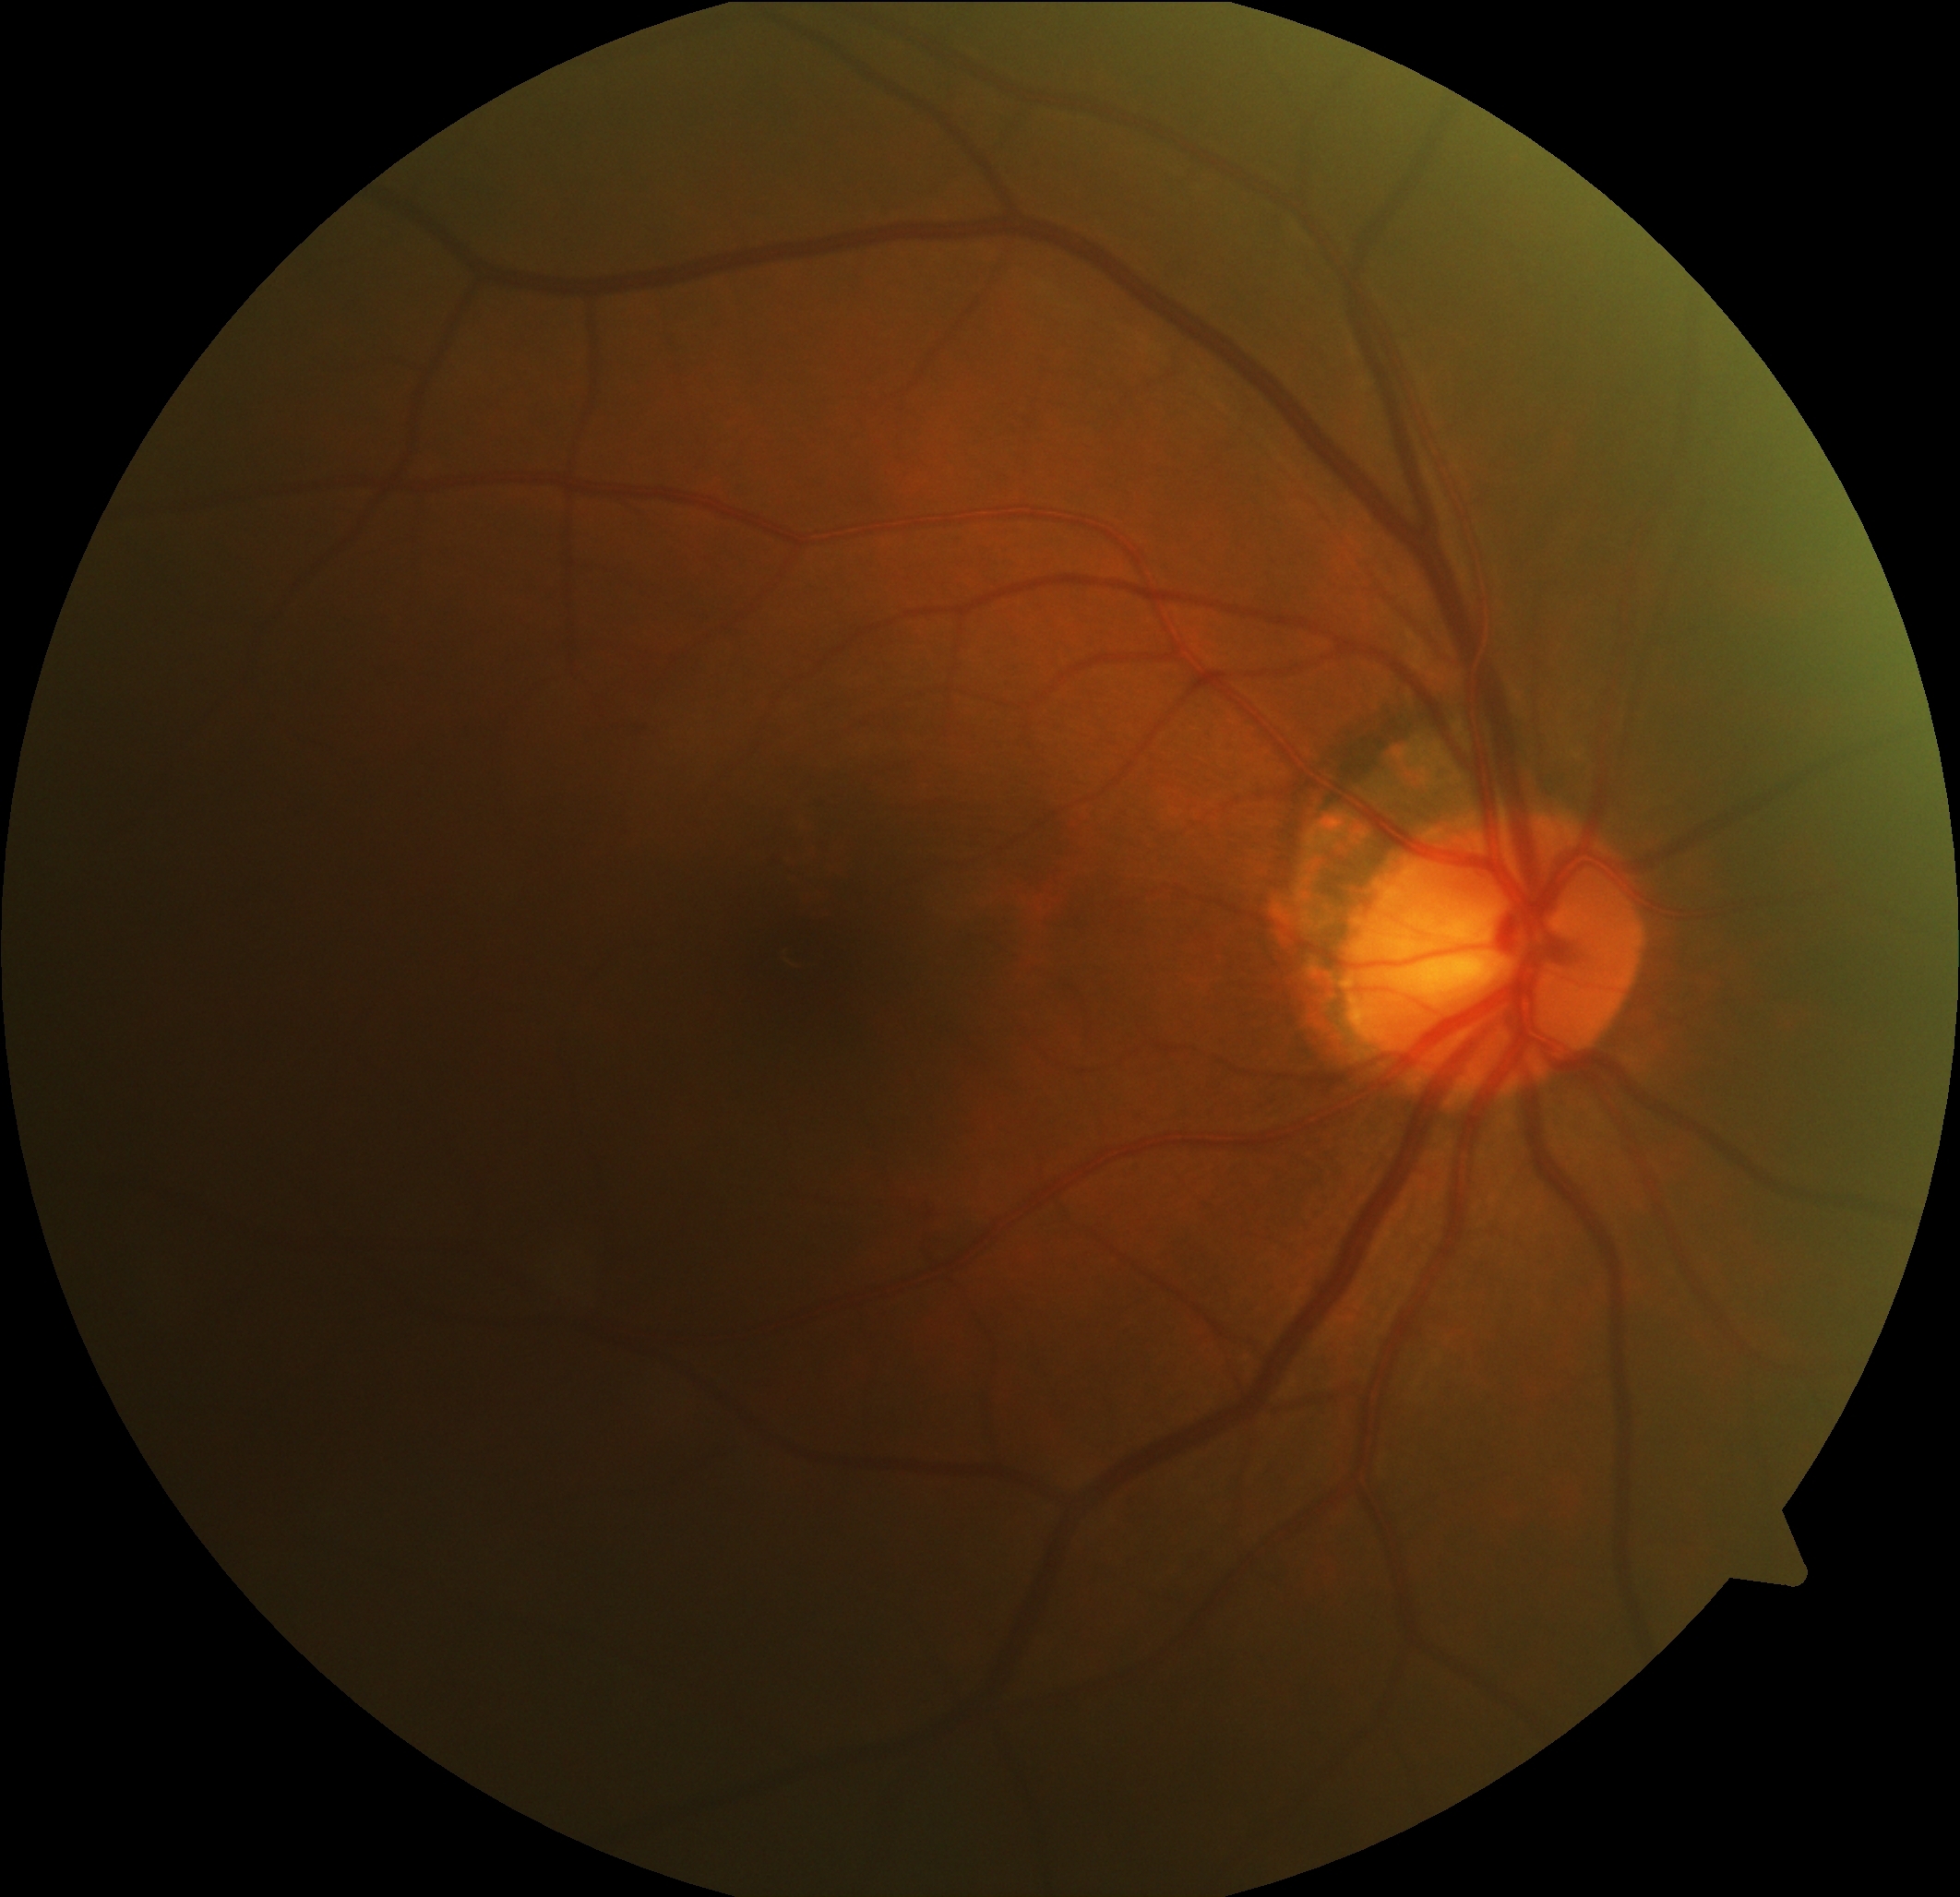
Diabetic retinopathy (DR): no apparent diabetic retinopathy (grade 0).